Camera: NIDEK AFC-230 · image size 848x848 · fundus photo — 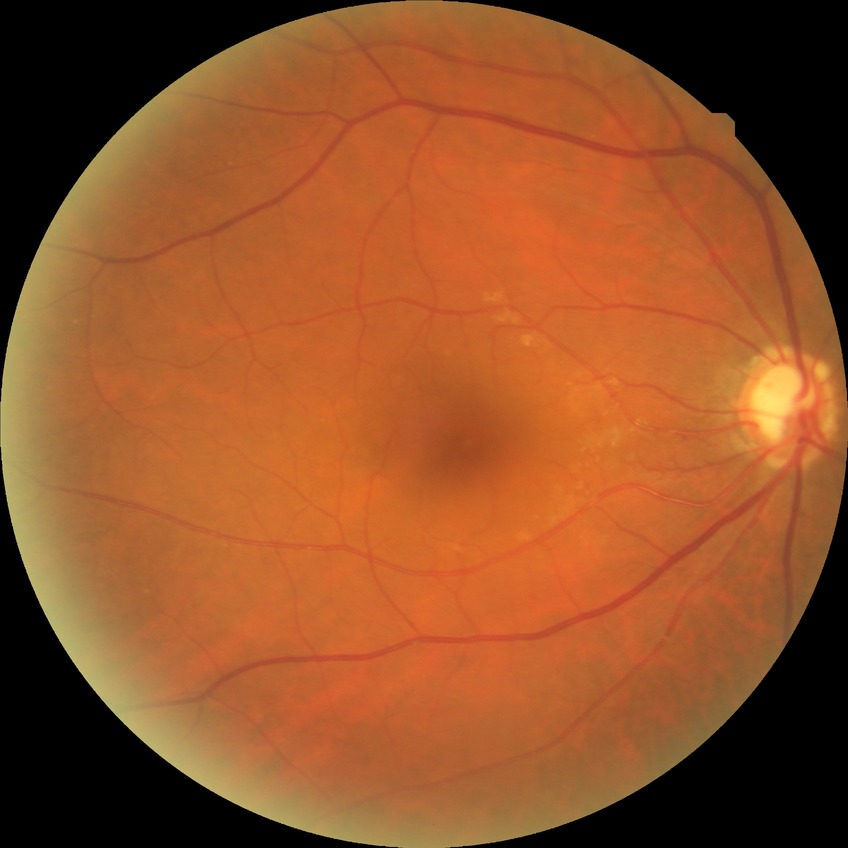
Modified Davis classification: no diabetic retinopathy.